45-degree field of view. Color fundus image
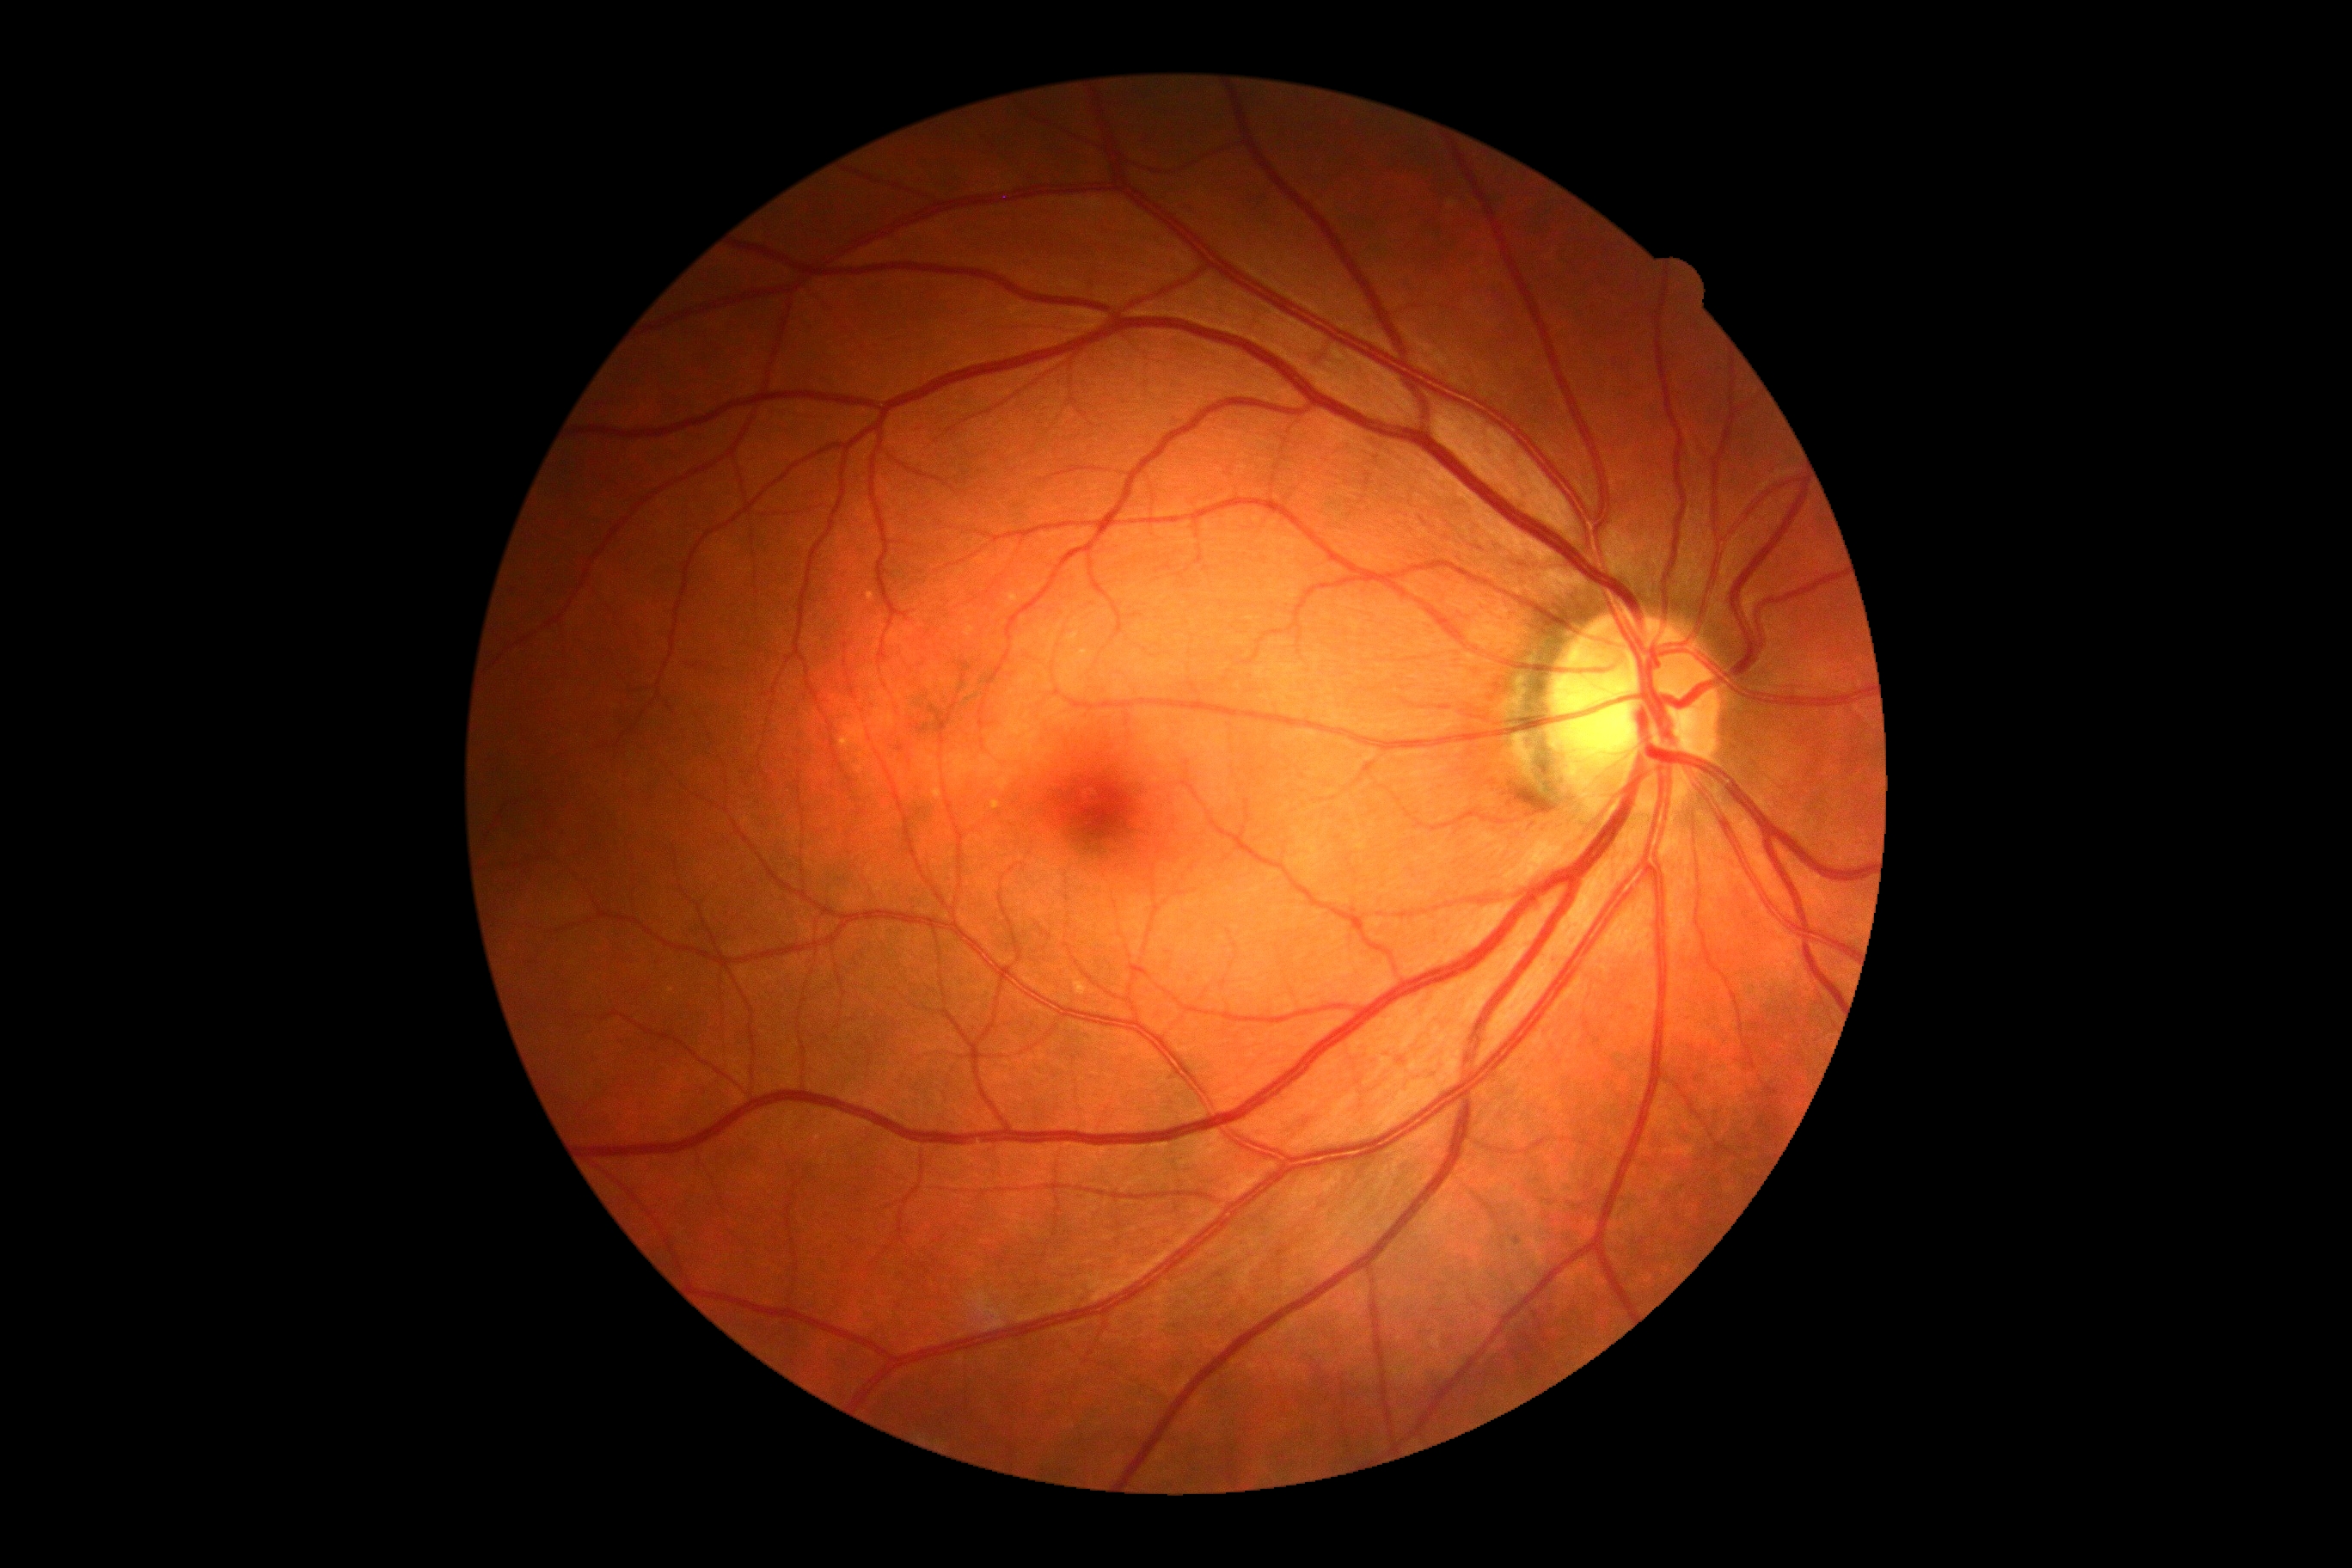
dr_grade: no apparent retinopathy (grade 0)